FOV: 45 degrees. Davis DR grading. Nonmydriatic:
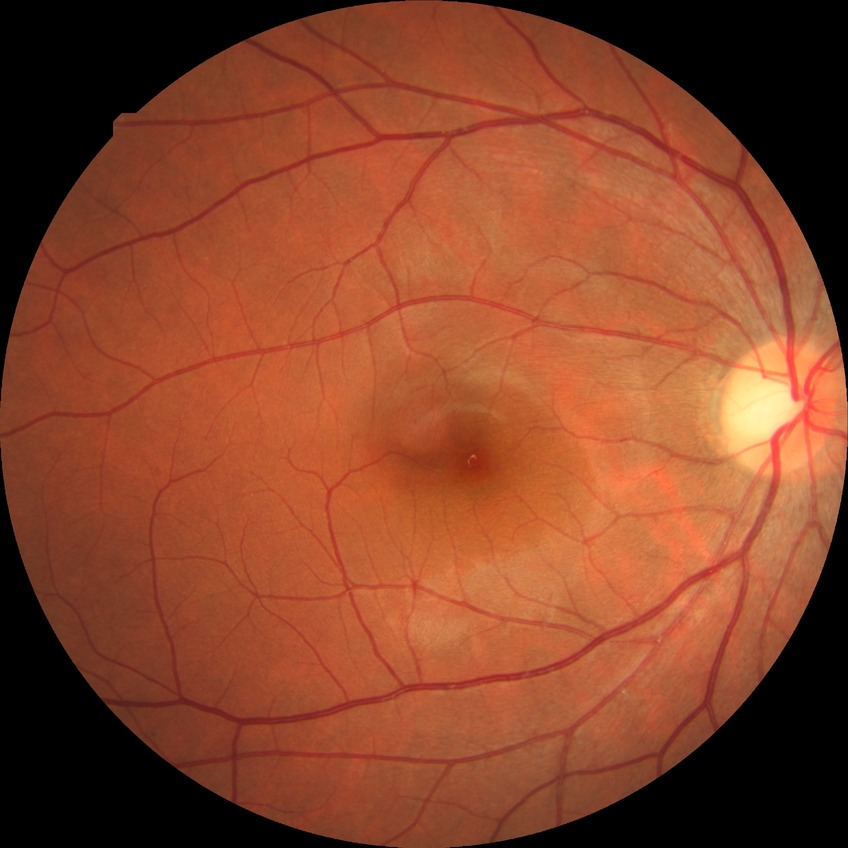
Diabetic retinopathy (DR): NDR (no diabetic retinopathy).